NIDEK AFC-230.
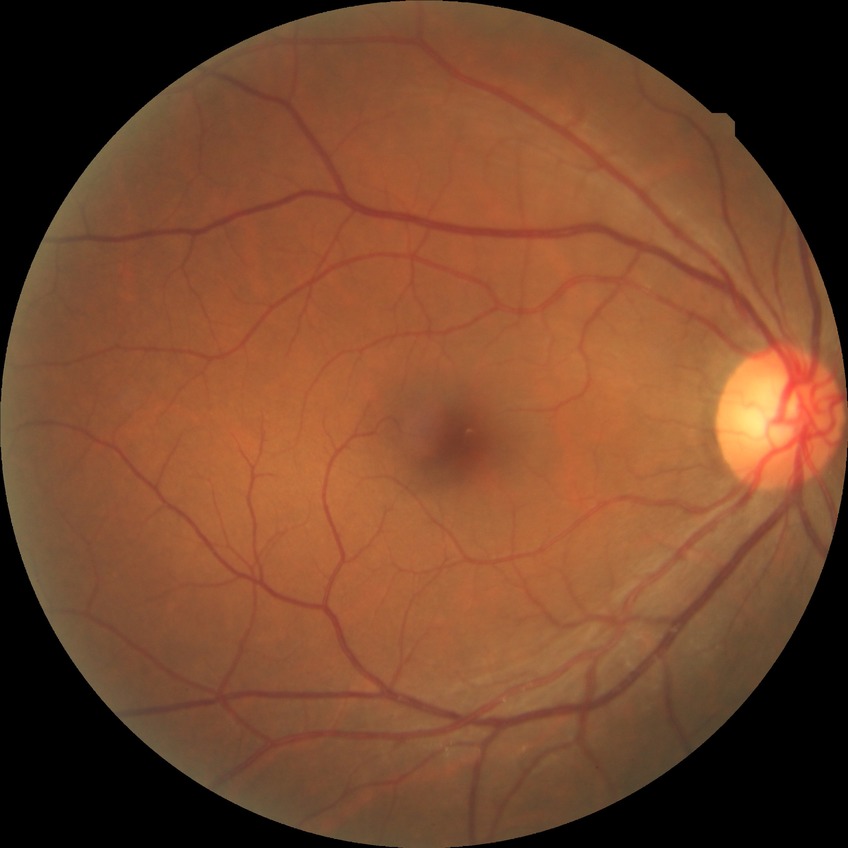 No DR findings. DR grade: NDR.